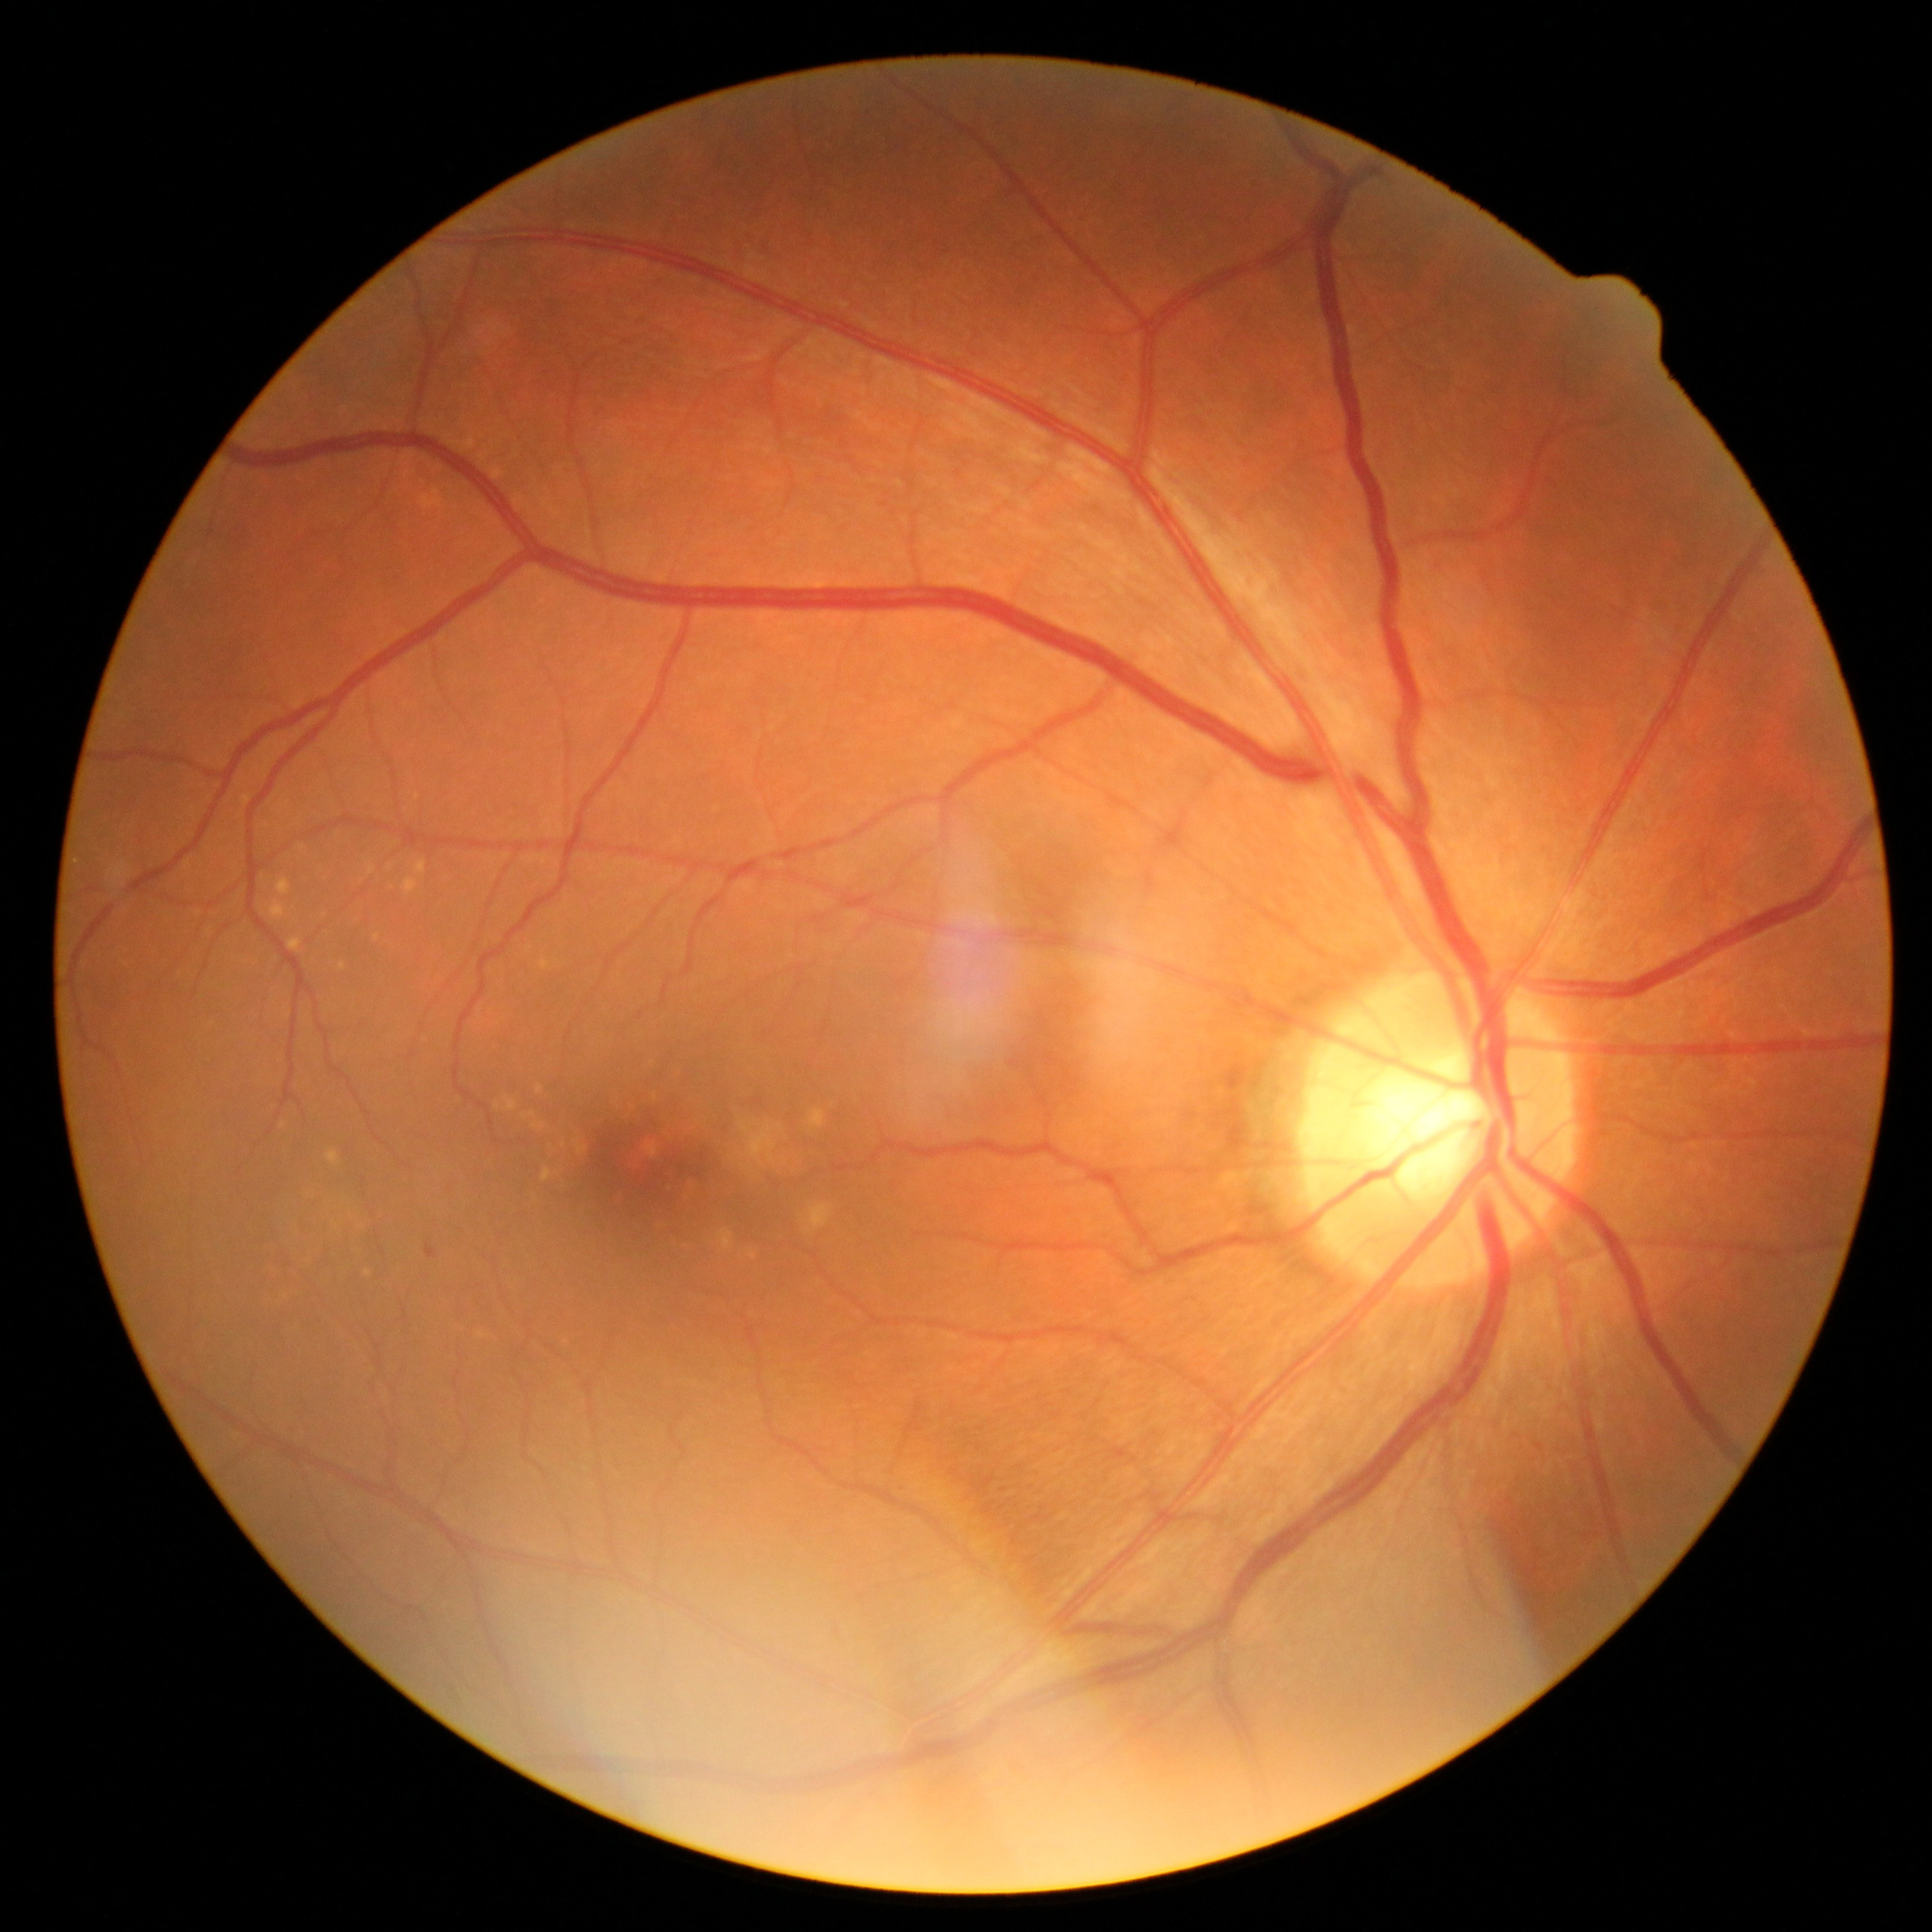
DR grade is 1 — presence of microaneurysms only.